Nidek AFC-330.
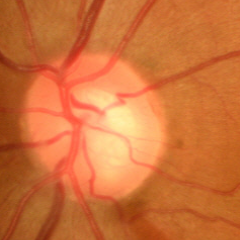 Glaucomatous changes are present.
Early-stage glaucoma.